Fundus photo; 45° FOV.
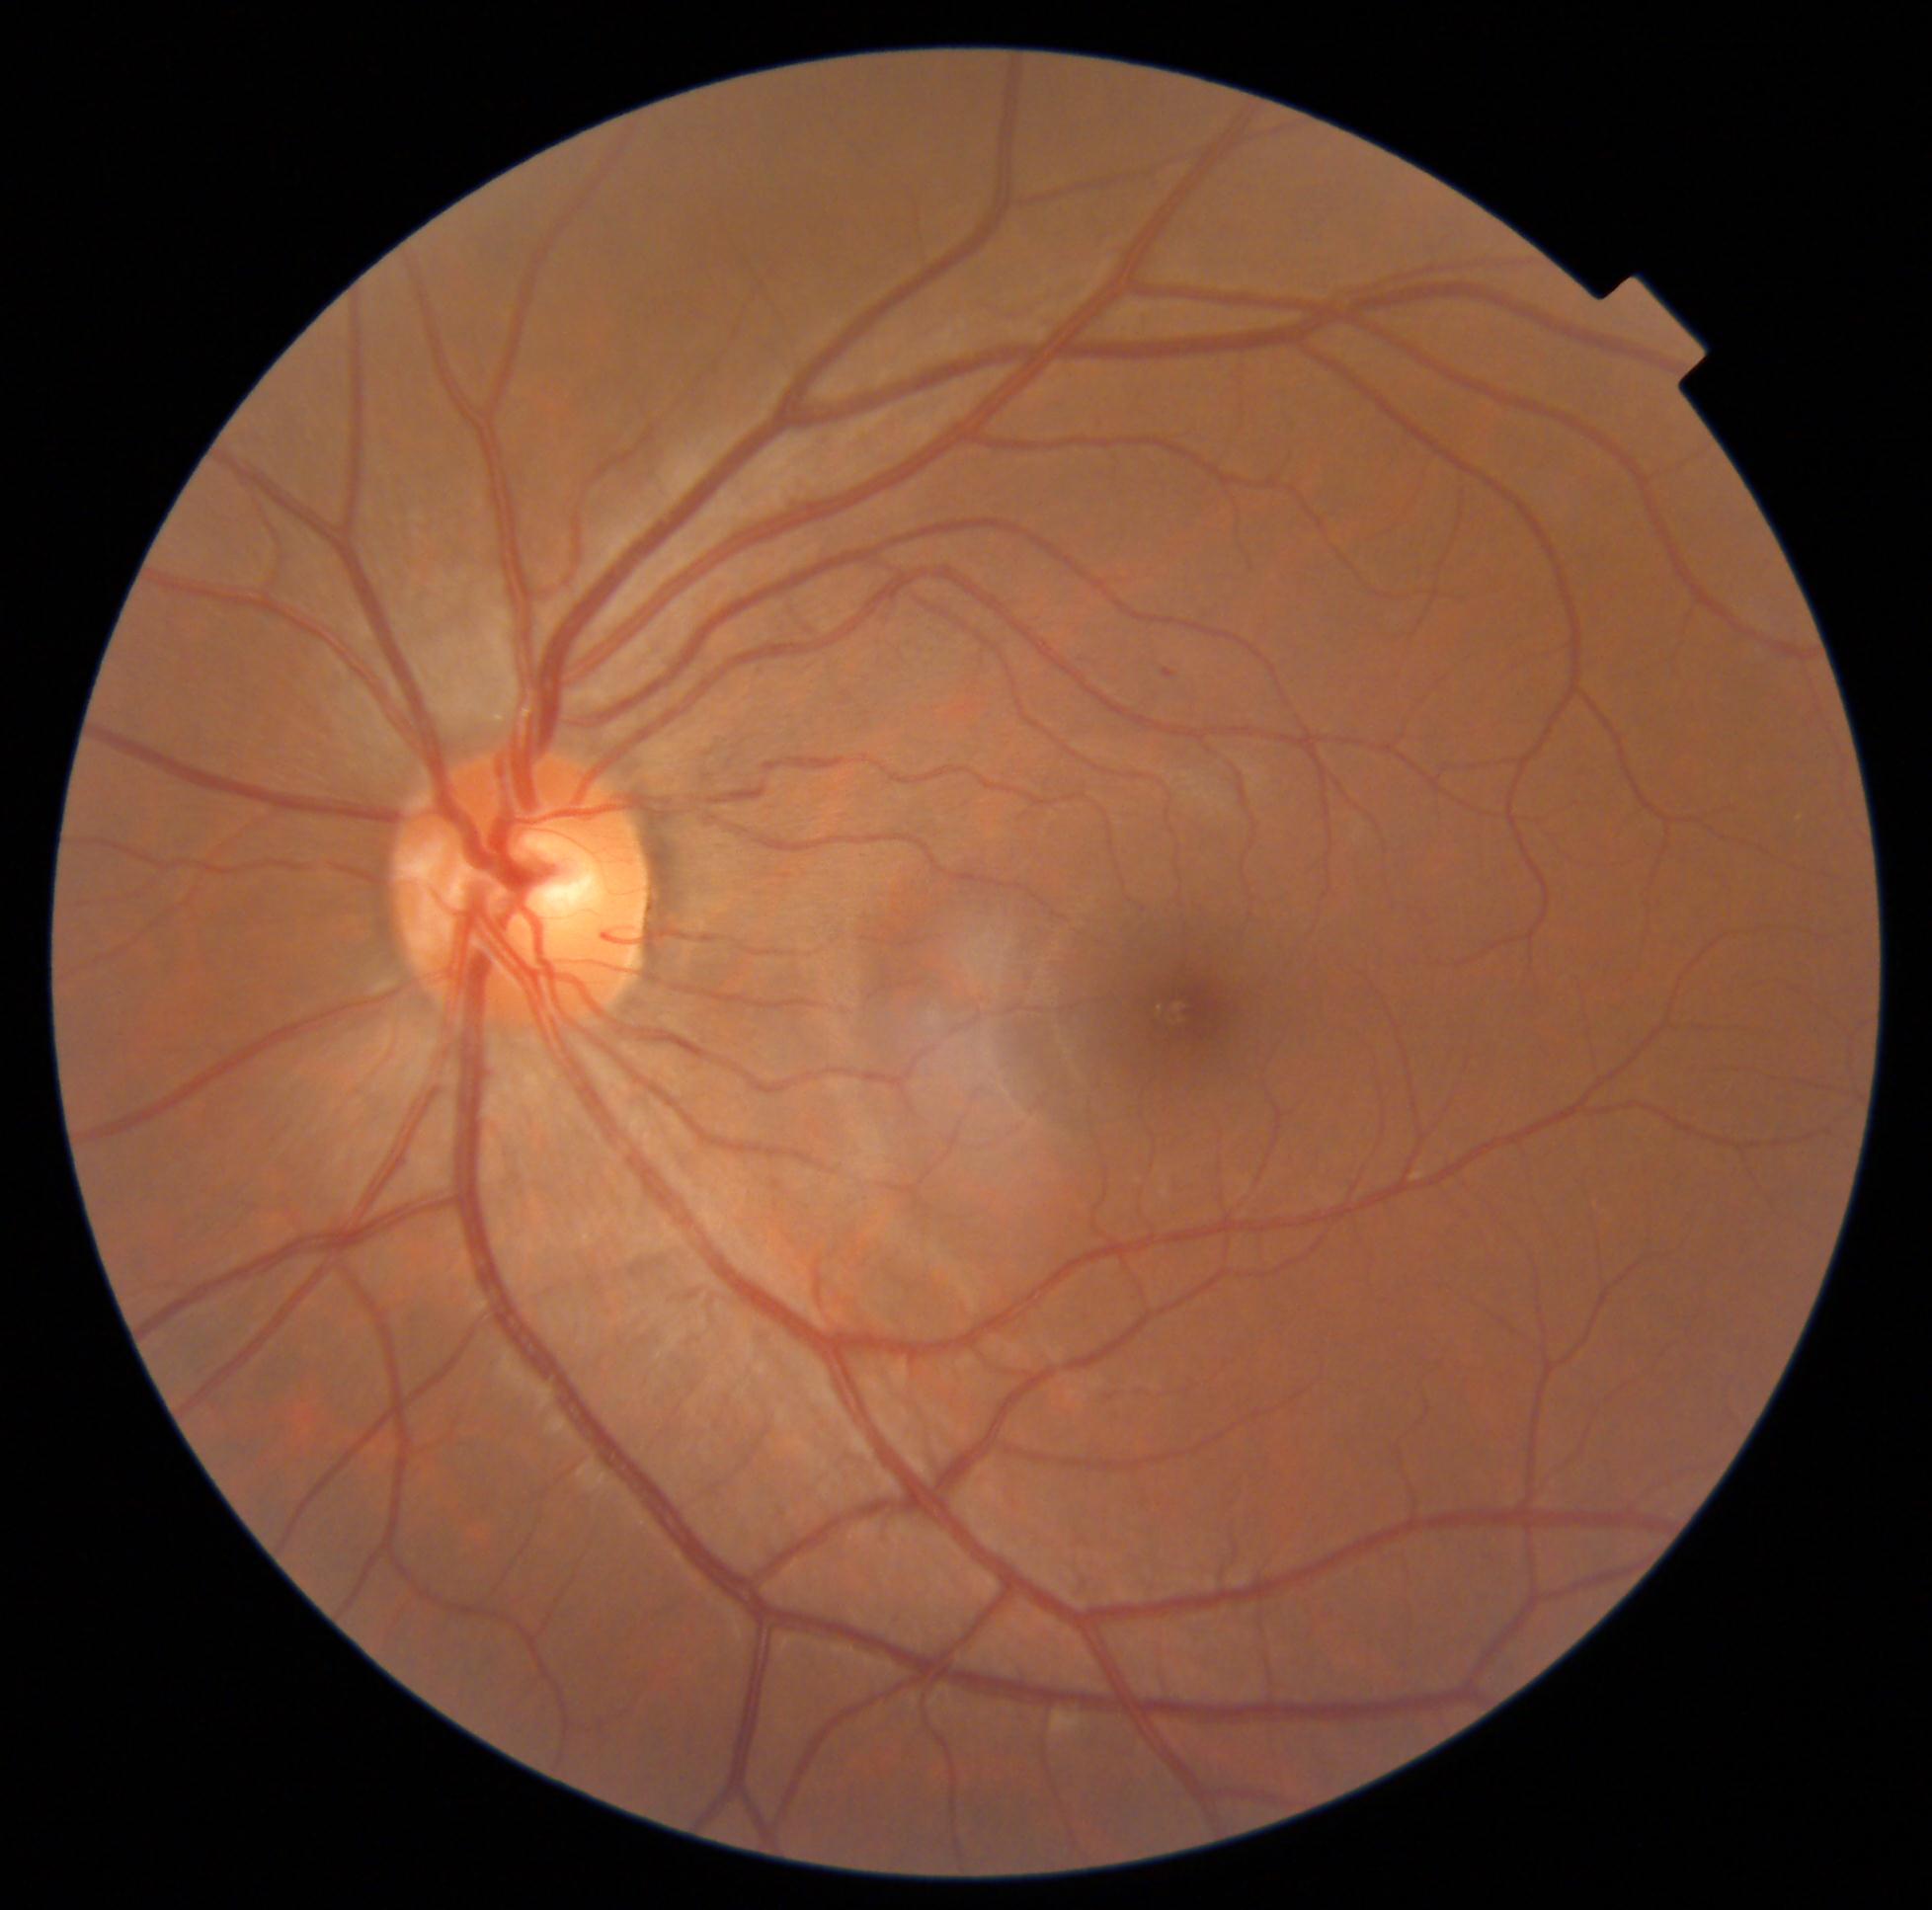   dr_grade: mild NPDR (1)
  dr_category: non-proliferative diabetic retinopathy